Fundus photo; FOV: 50 degrees — 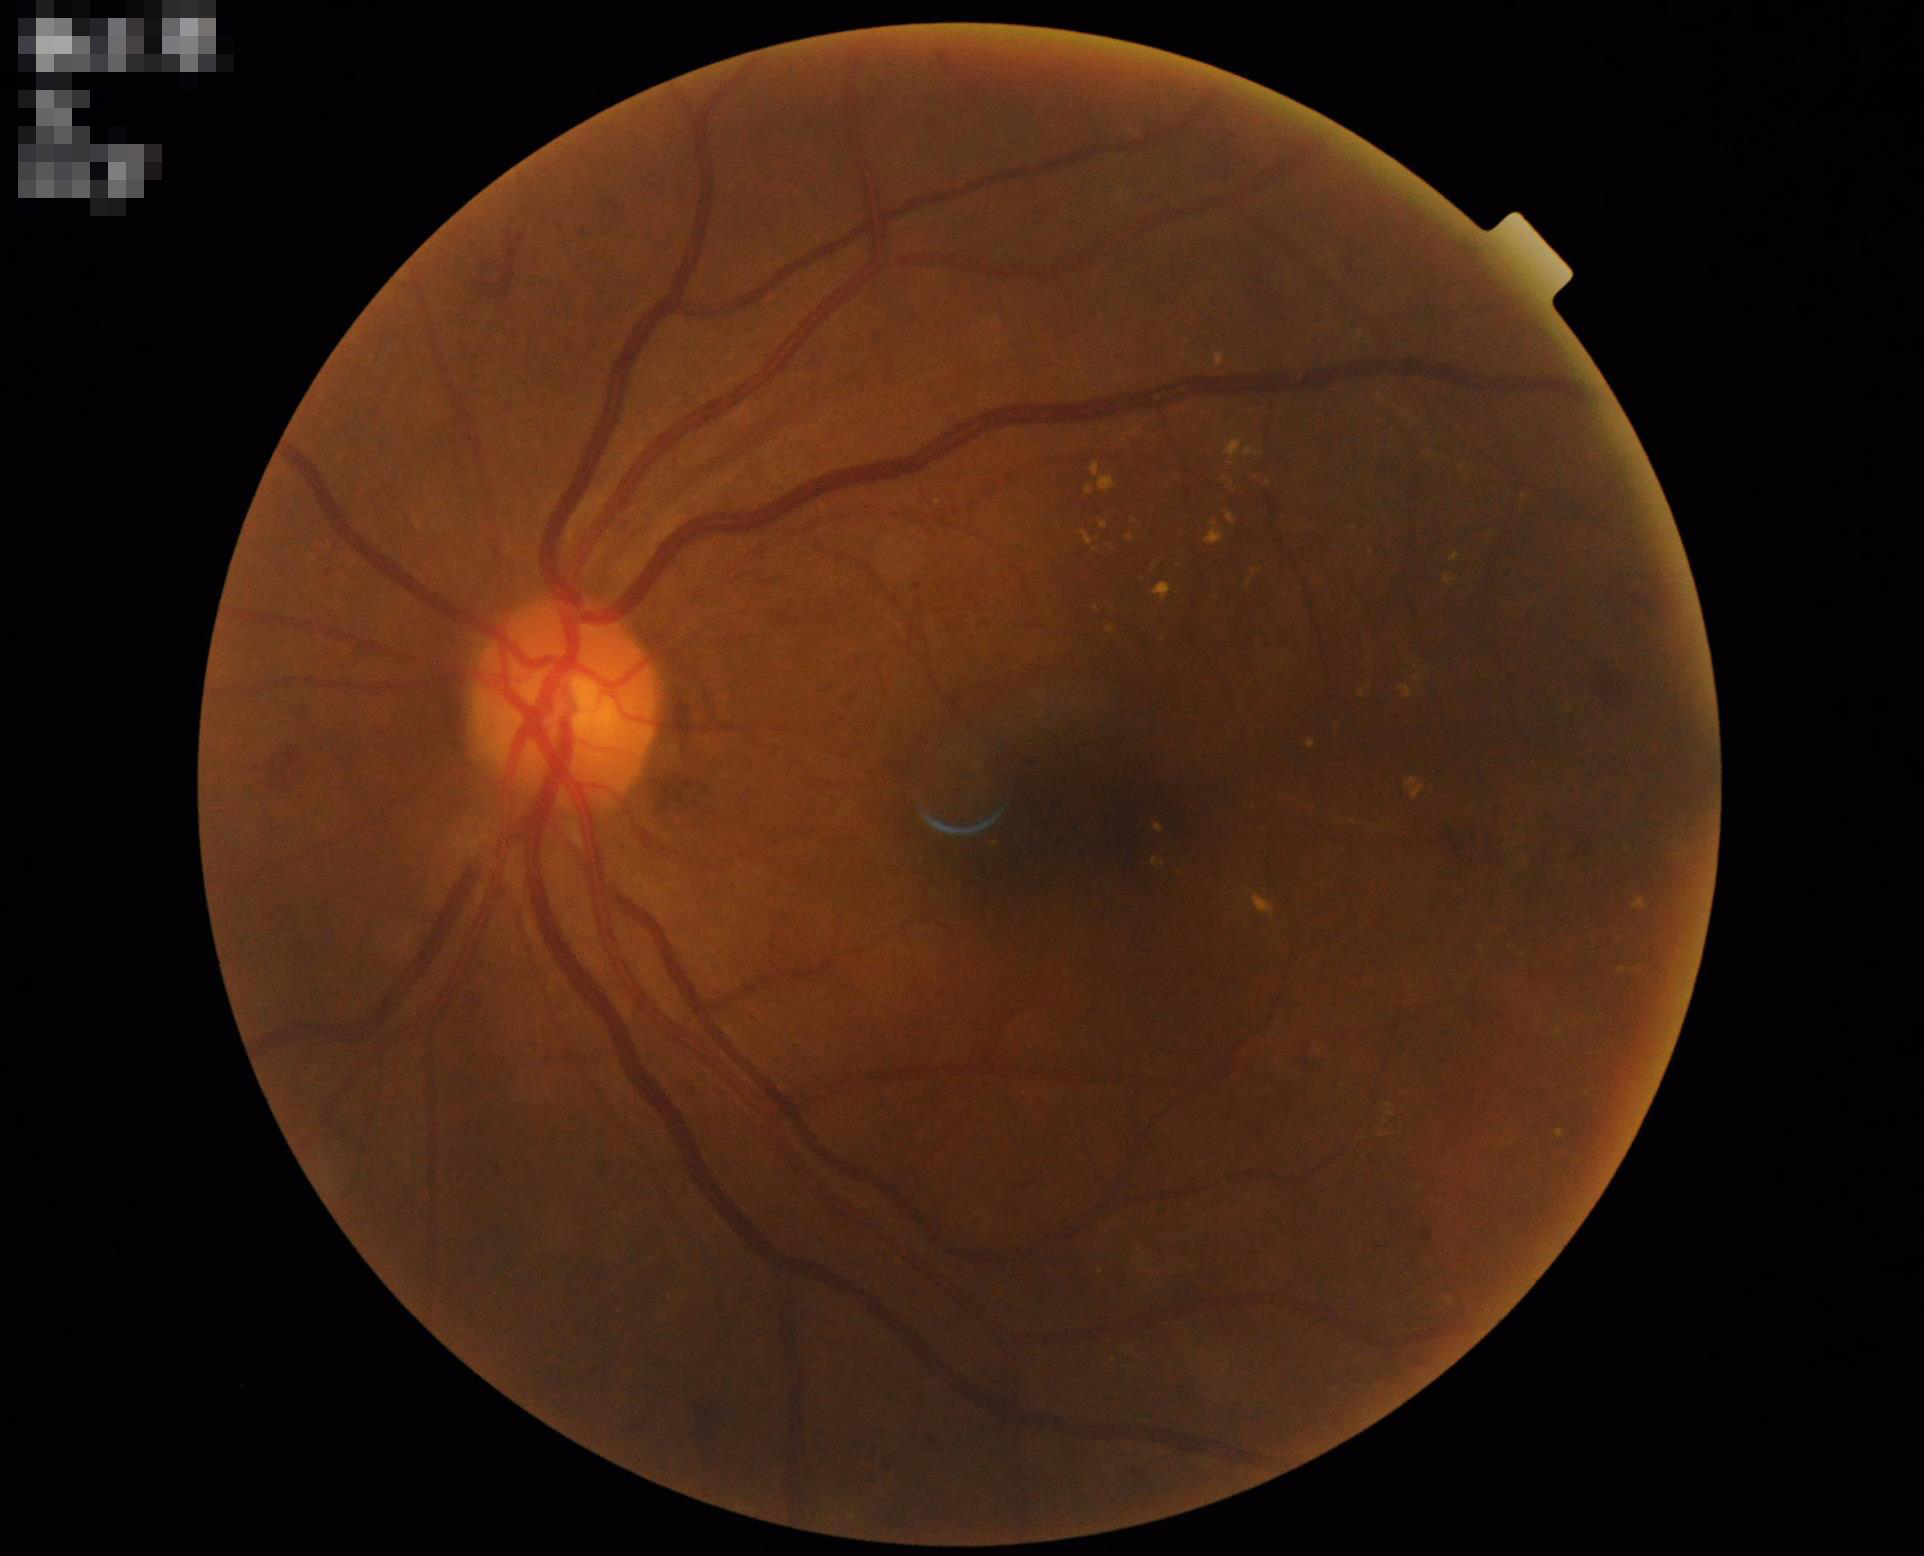 contrast: satisfactory
clarity: sharp
overall_quality: good